Color fundus photograph
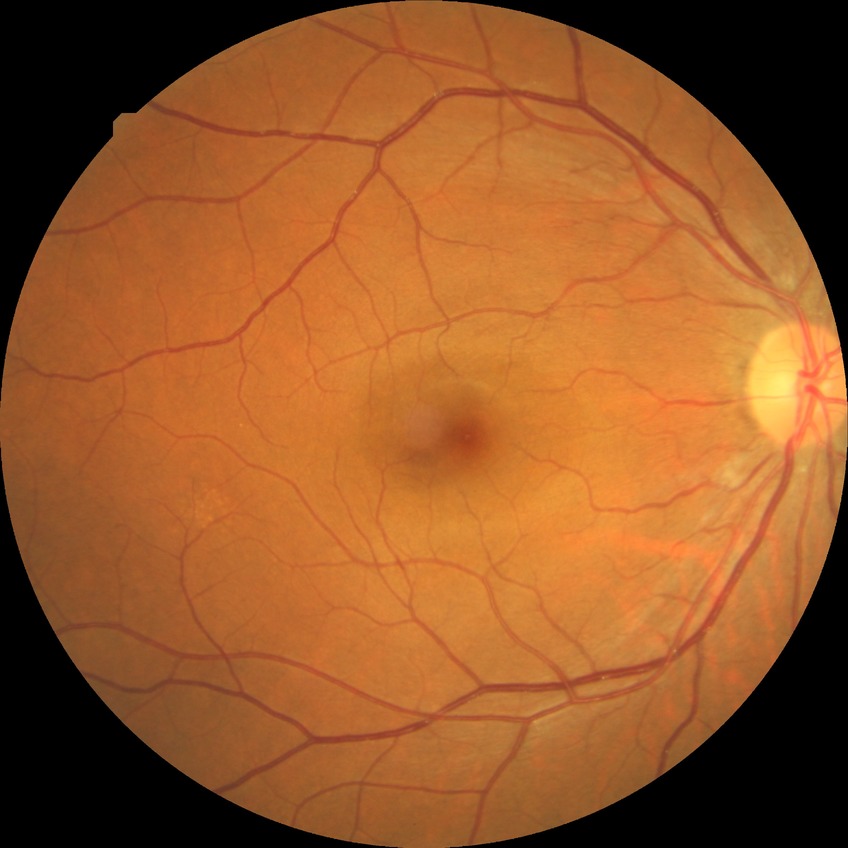

Diabetic retinopathy stage is no diabetic retinopathy.